Retinal fundus photograph, non-mydriatic fundus camera, centered on the optic disc.
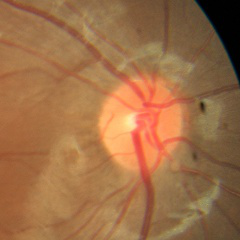

Q: Is glaucoma present?
A: No glaucomatous findings.